Nonmydriatic fundus photograph · 848x848px · diabetic retinopathy graded by the modified Davis classification · NIDEK AFC-230 fundus camera · 45° field of view
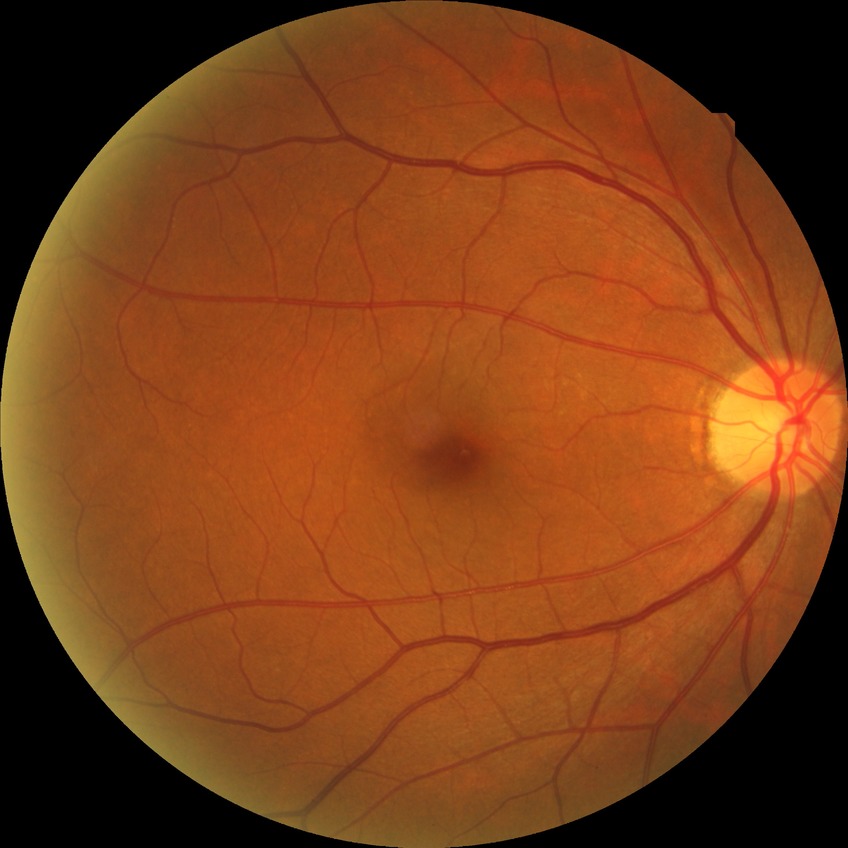

Modified Davis classification: no diabetic retinopathy.